Color fundus image: 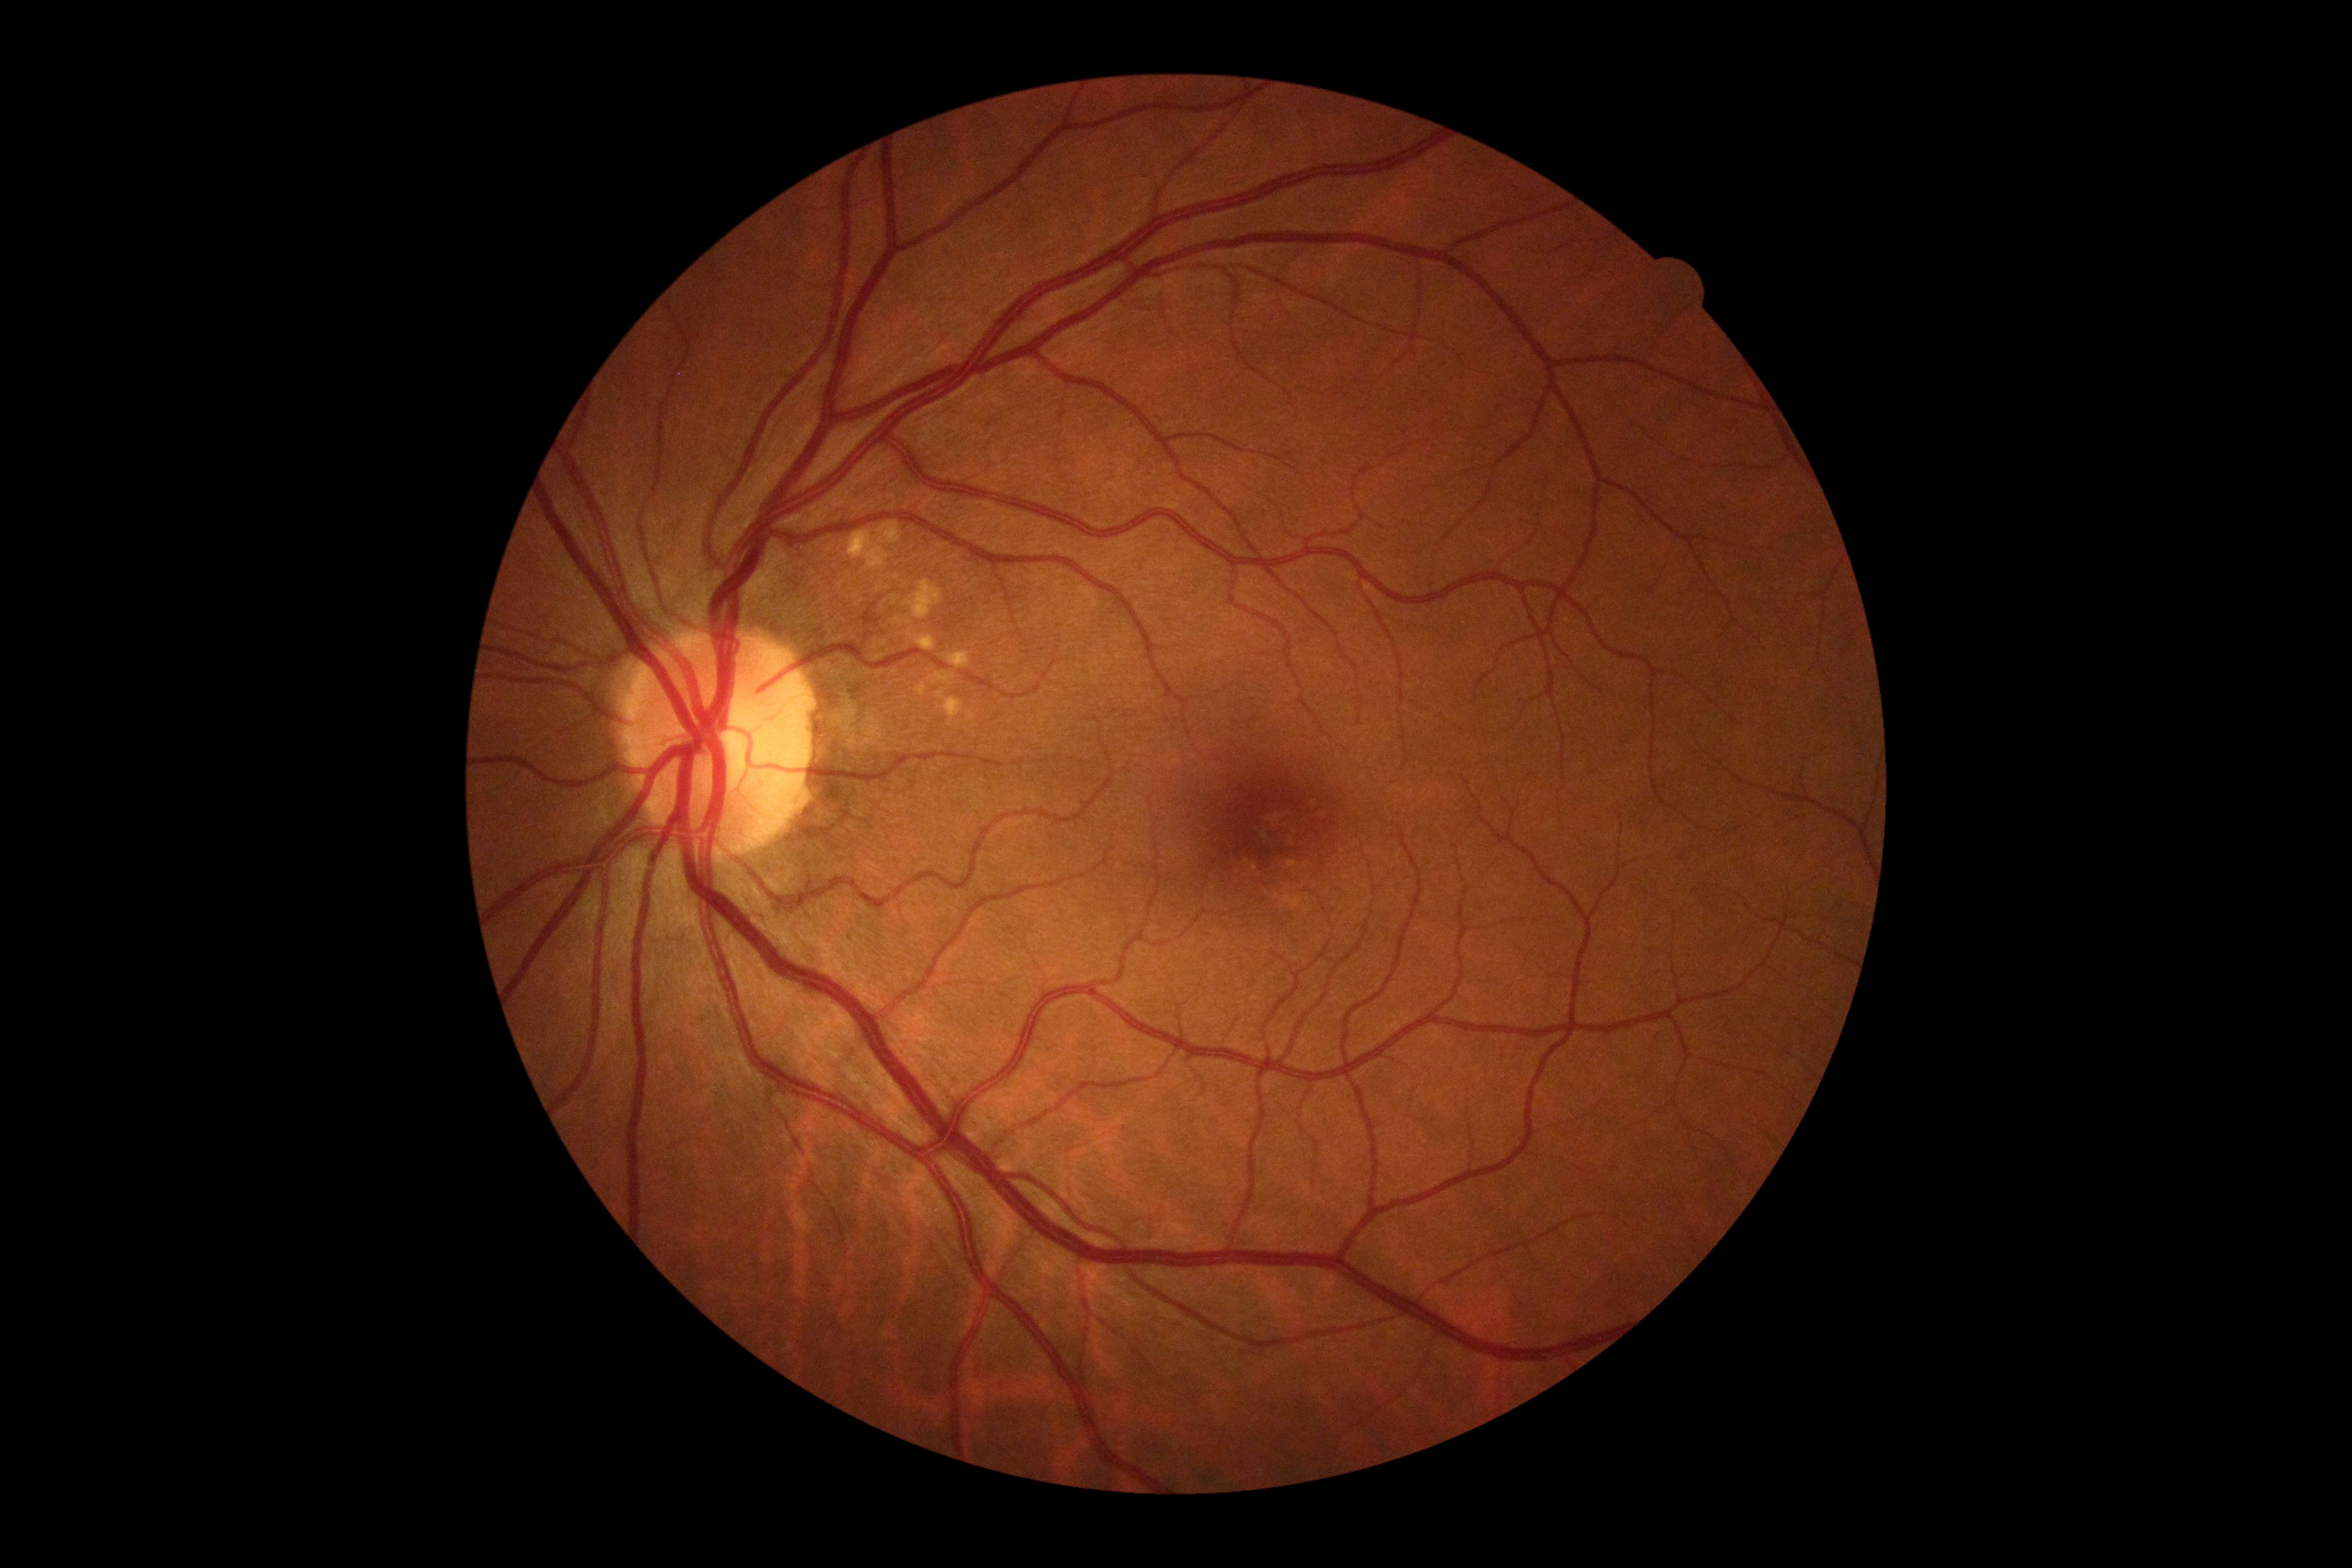
Diabetic retinopathy (DR) is 0/4.